Color fundus image — 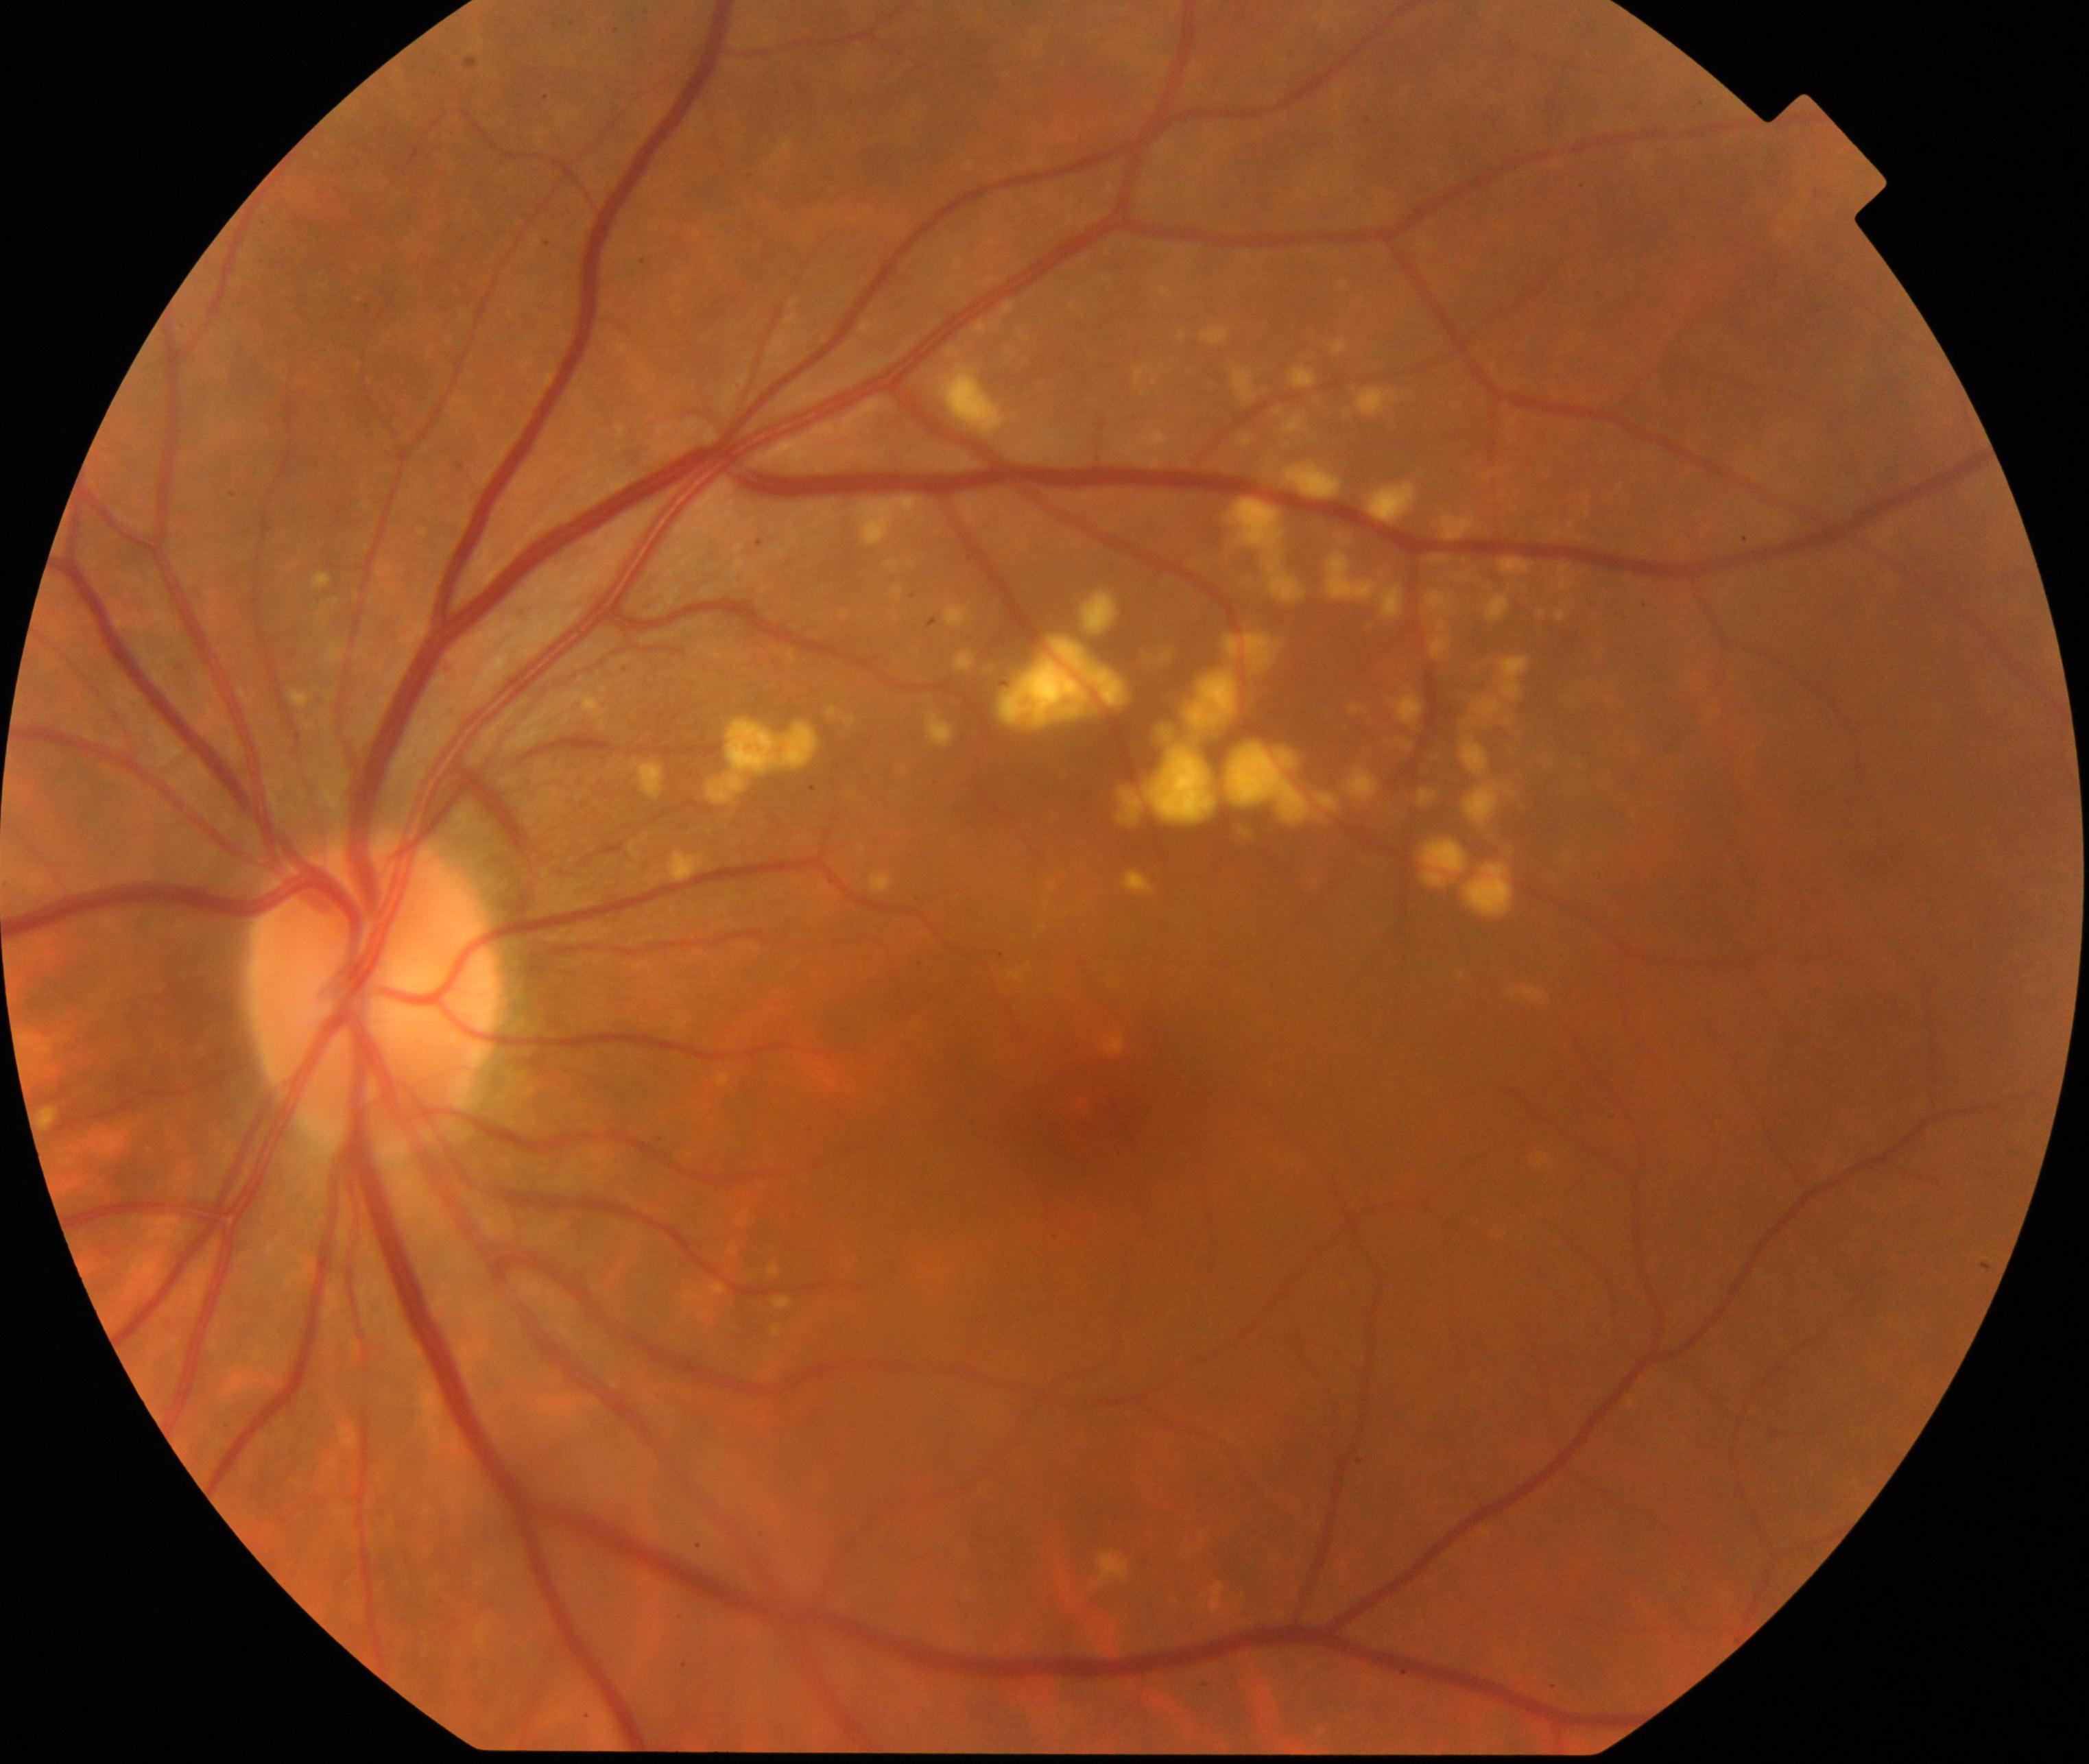

The image shows yellow-white spots or flecks.